Image size 2212x1659: 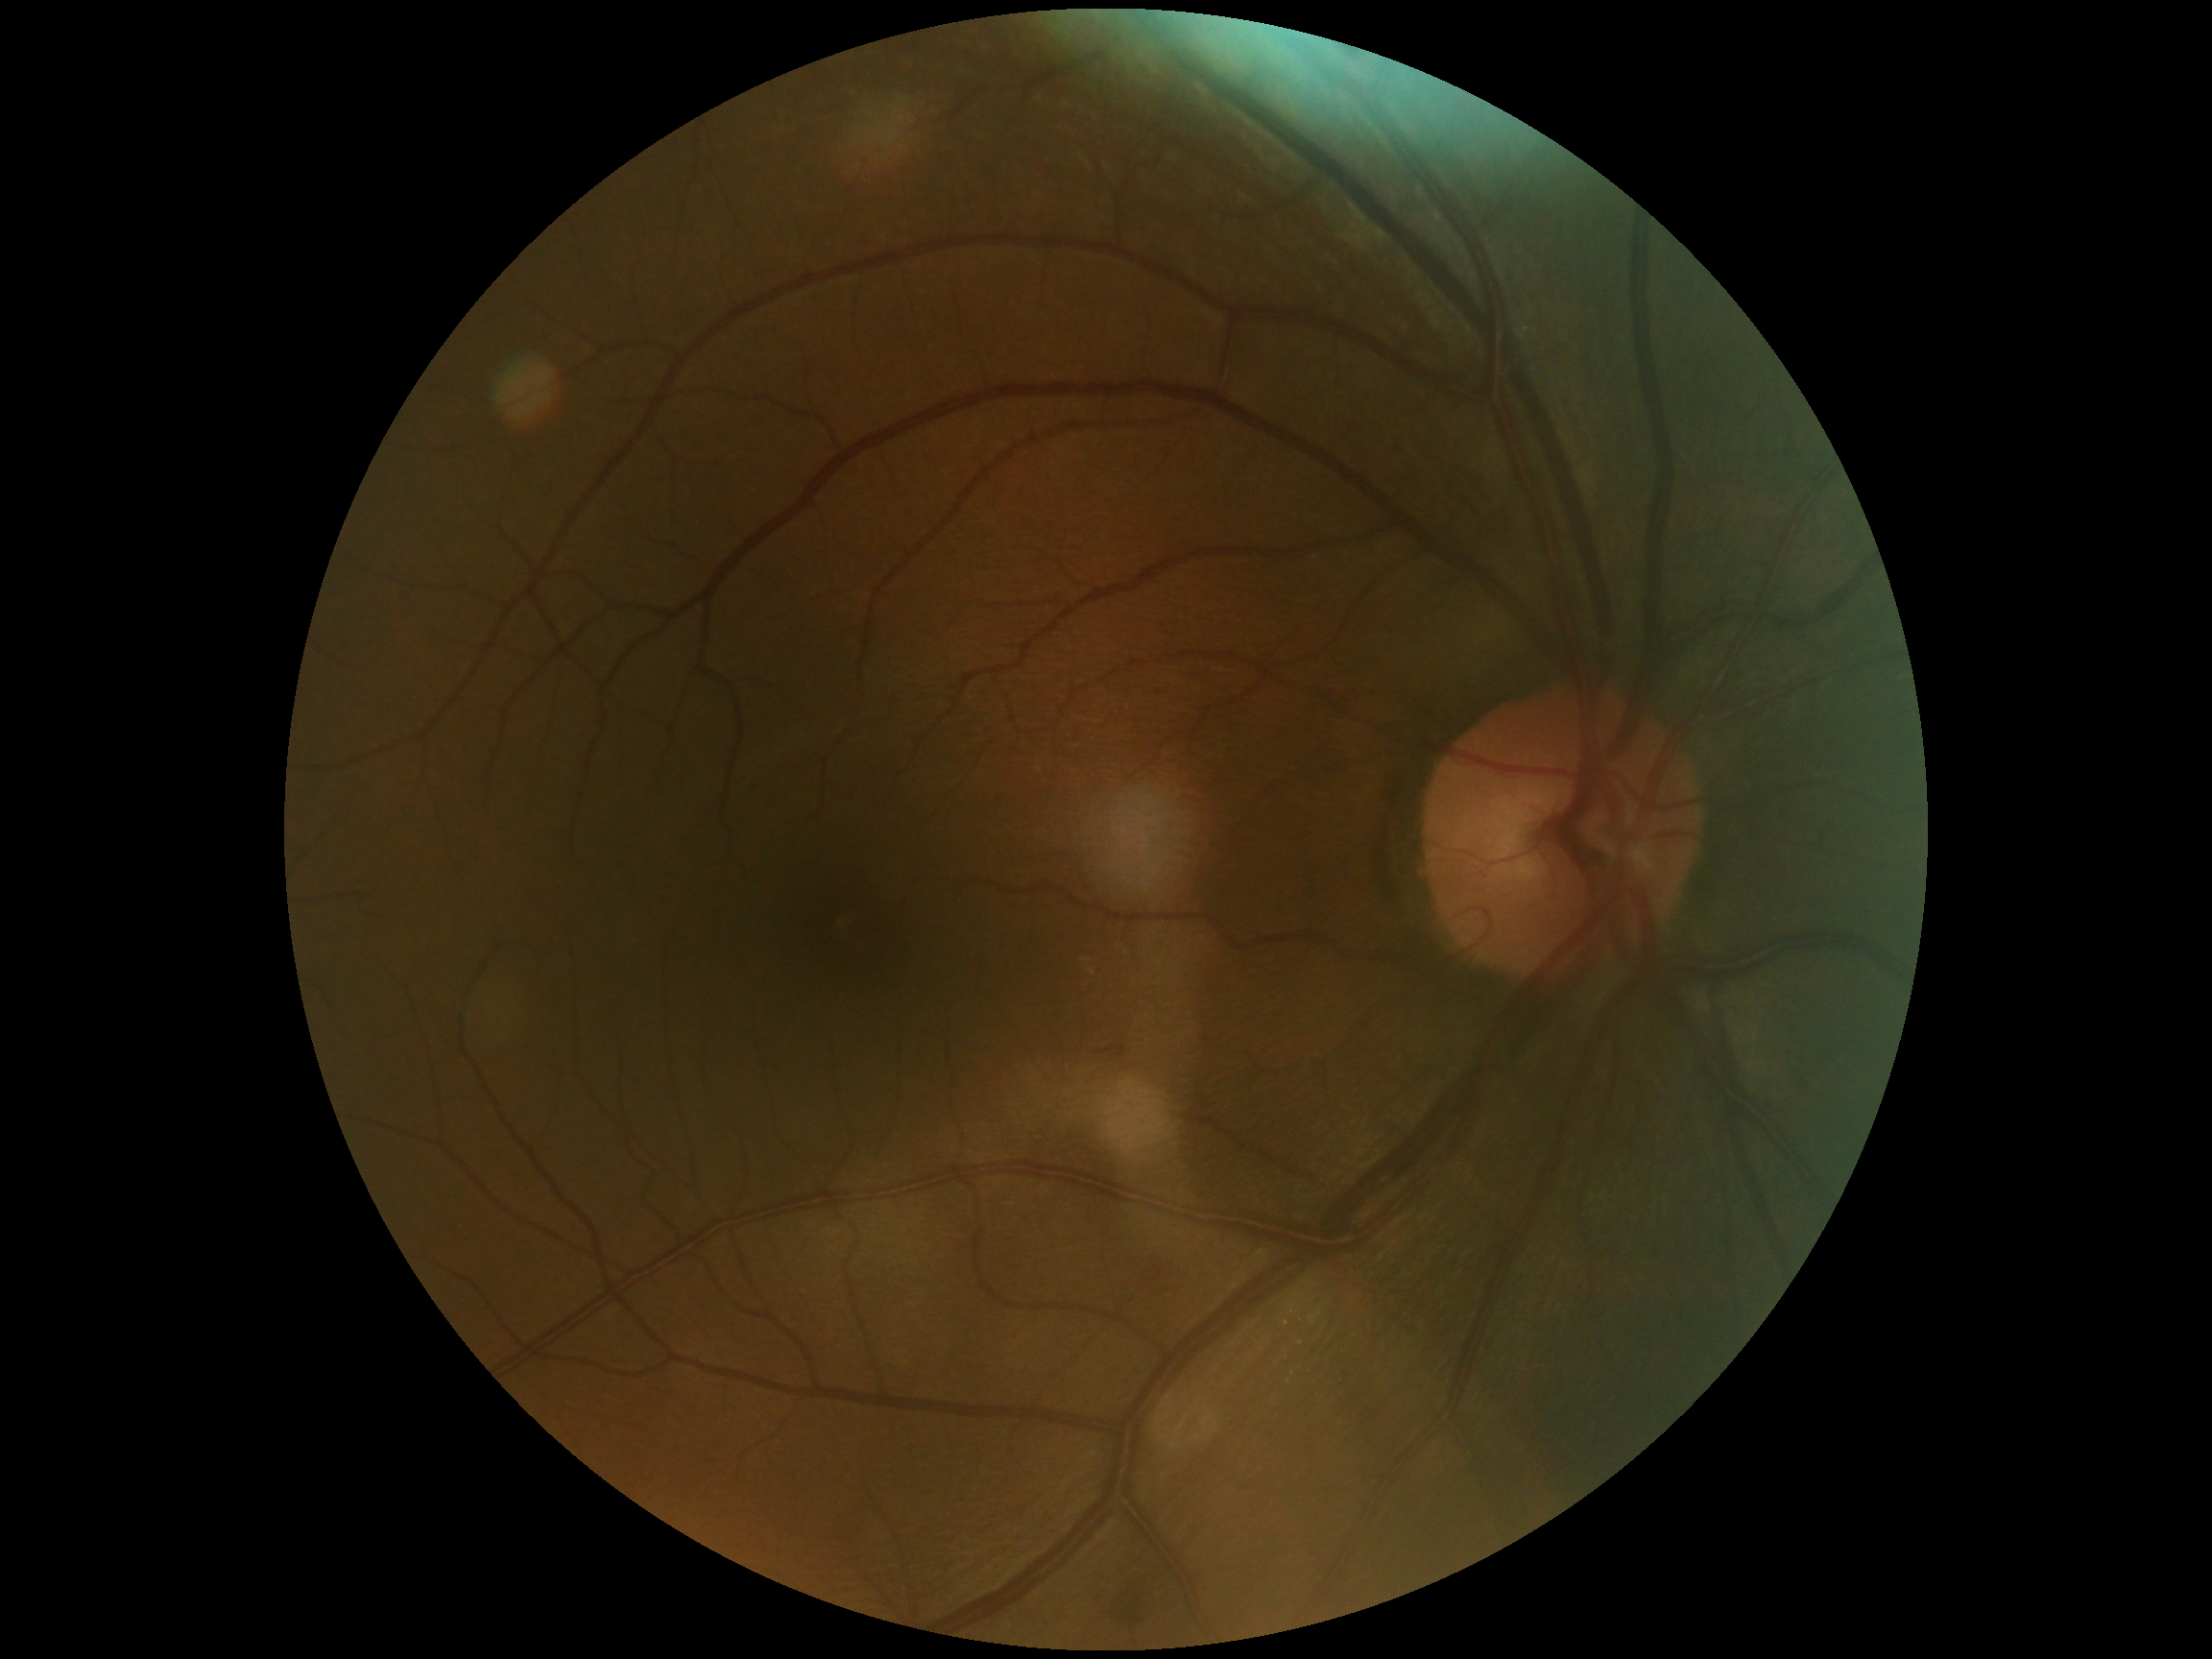

DR stage is no apparent diabetic retinopathy (grade 0).